Wide-field contact fundus photograph of an infant; 1240x1240; 100° field of view (Phoenix ICON) — 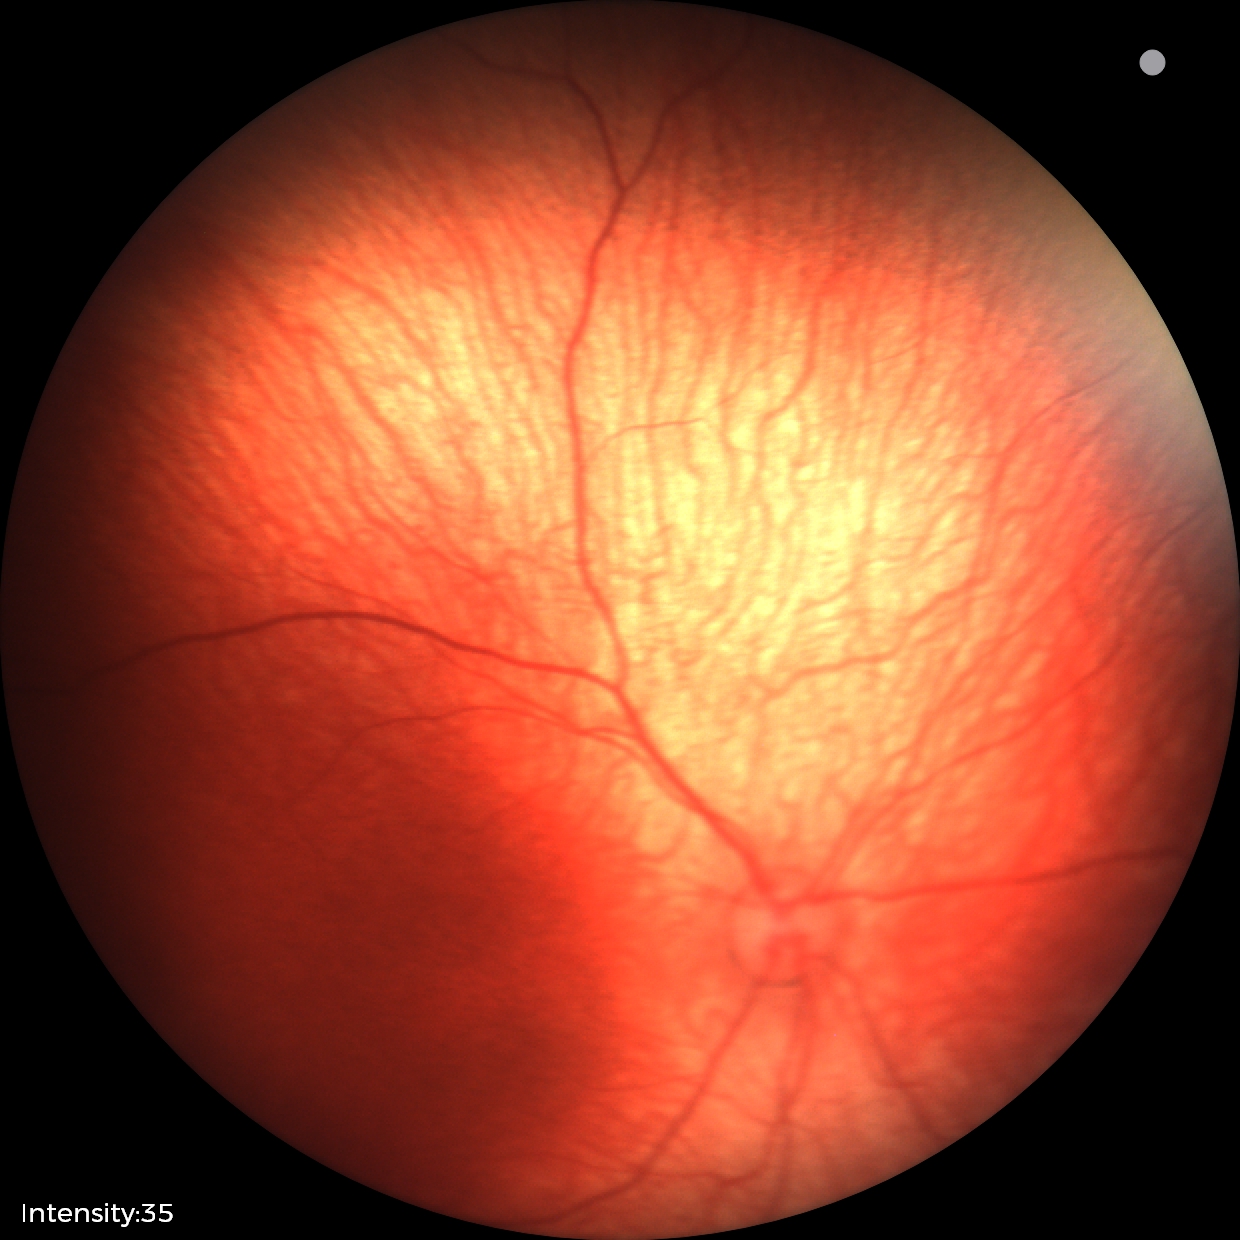

Normal screening examination.